Graded on the modified Davis scale. NIDEK AFC-230 fundus camera
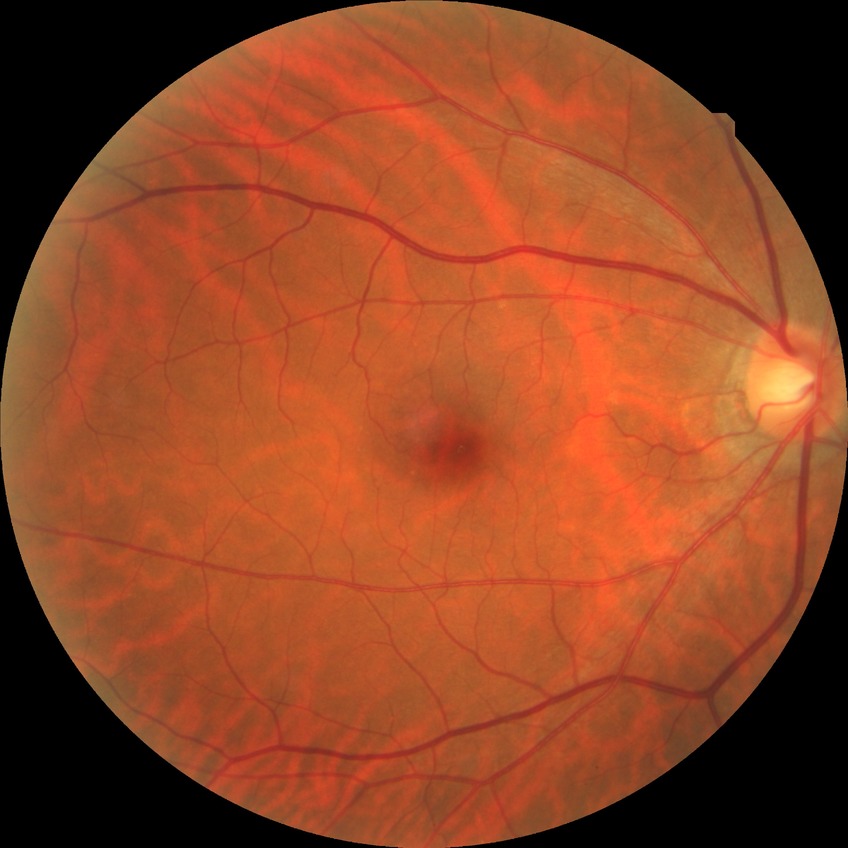 Diabetic retinopathy (DR) is NDR (no diabetic retinopathy).